Image size 1240x1240. Pediatric wide-field fundus photograph
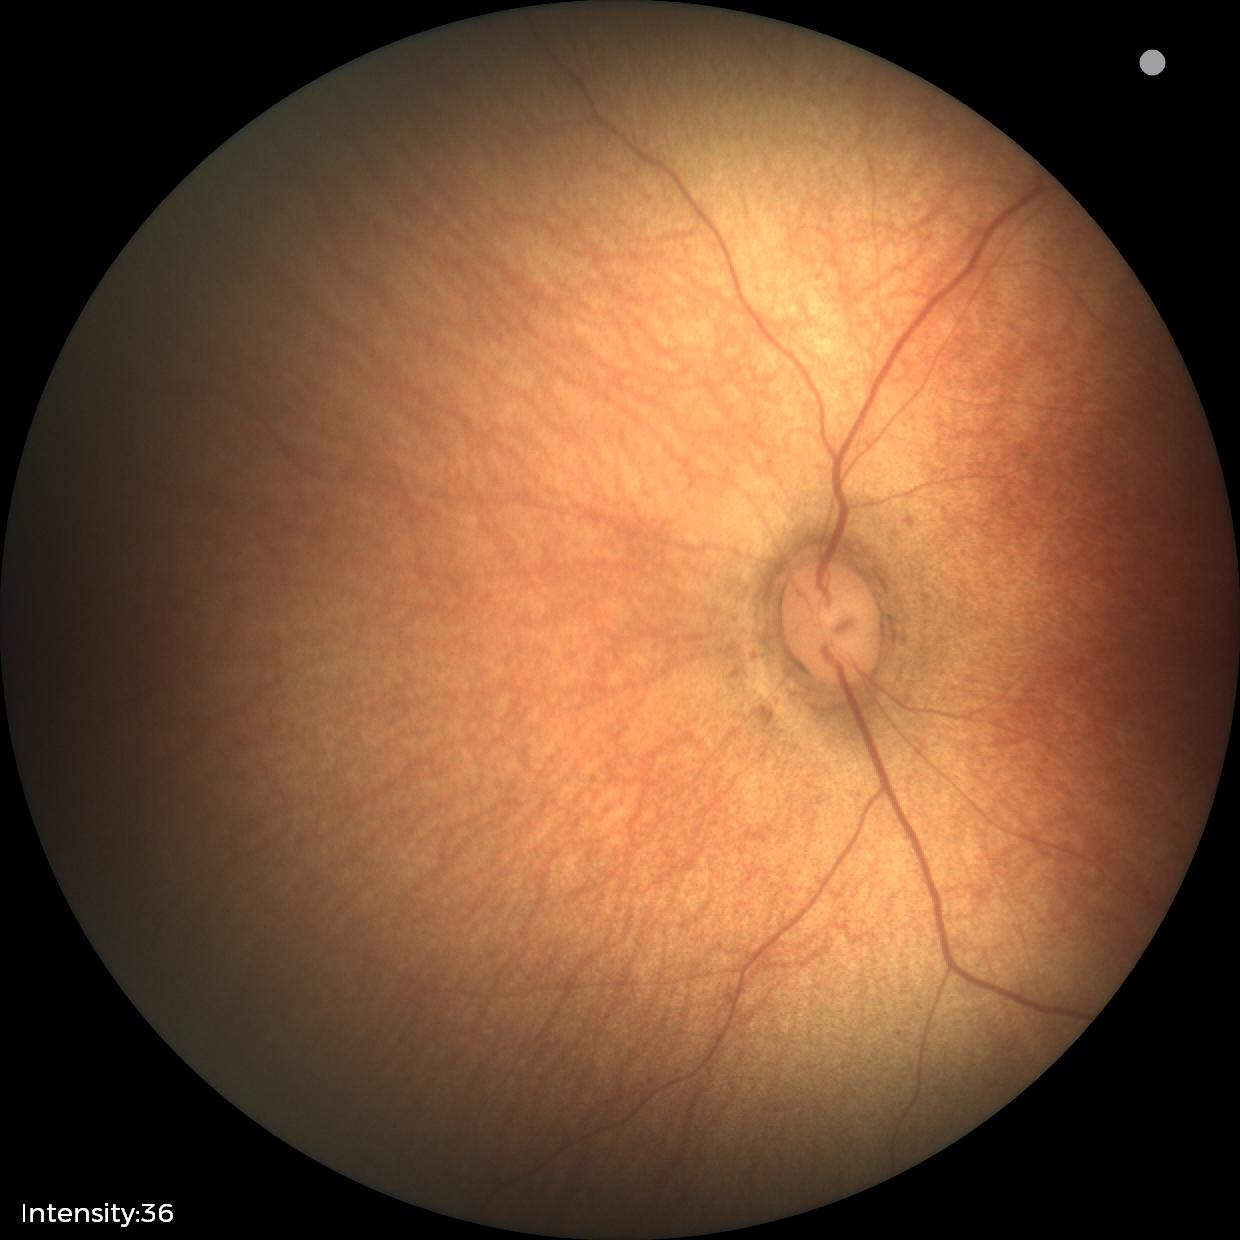 Screening examination with no abnormal retinal findings.